Modified Davis grading.
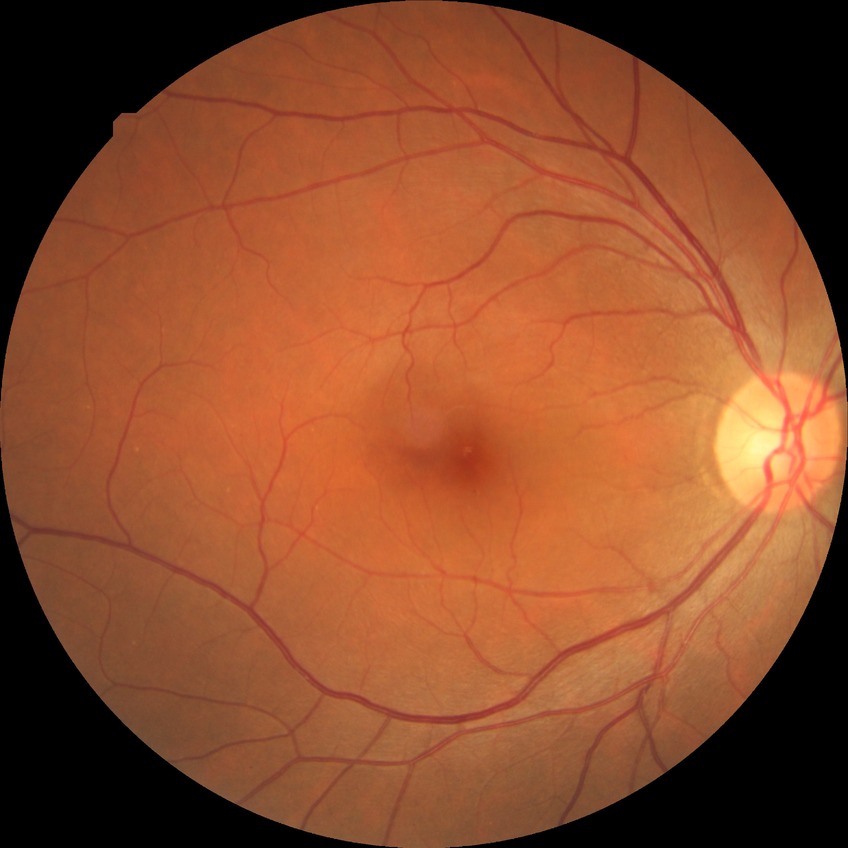
Davis stage = NDR.